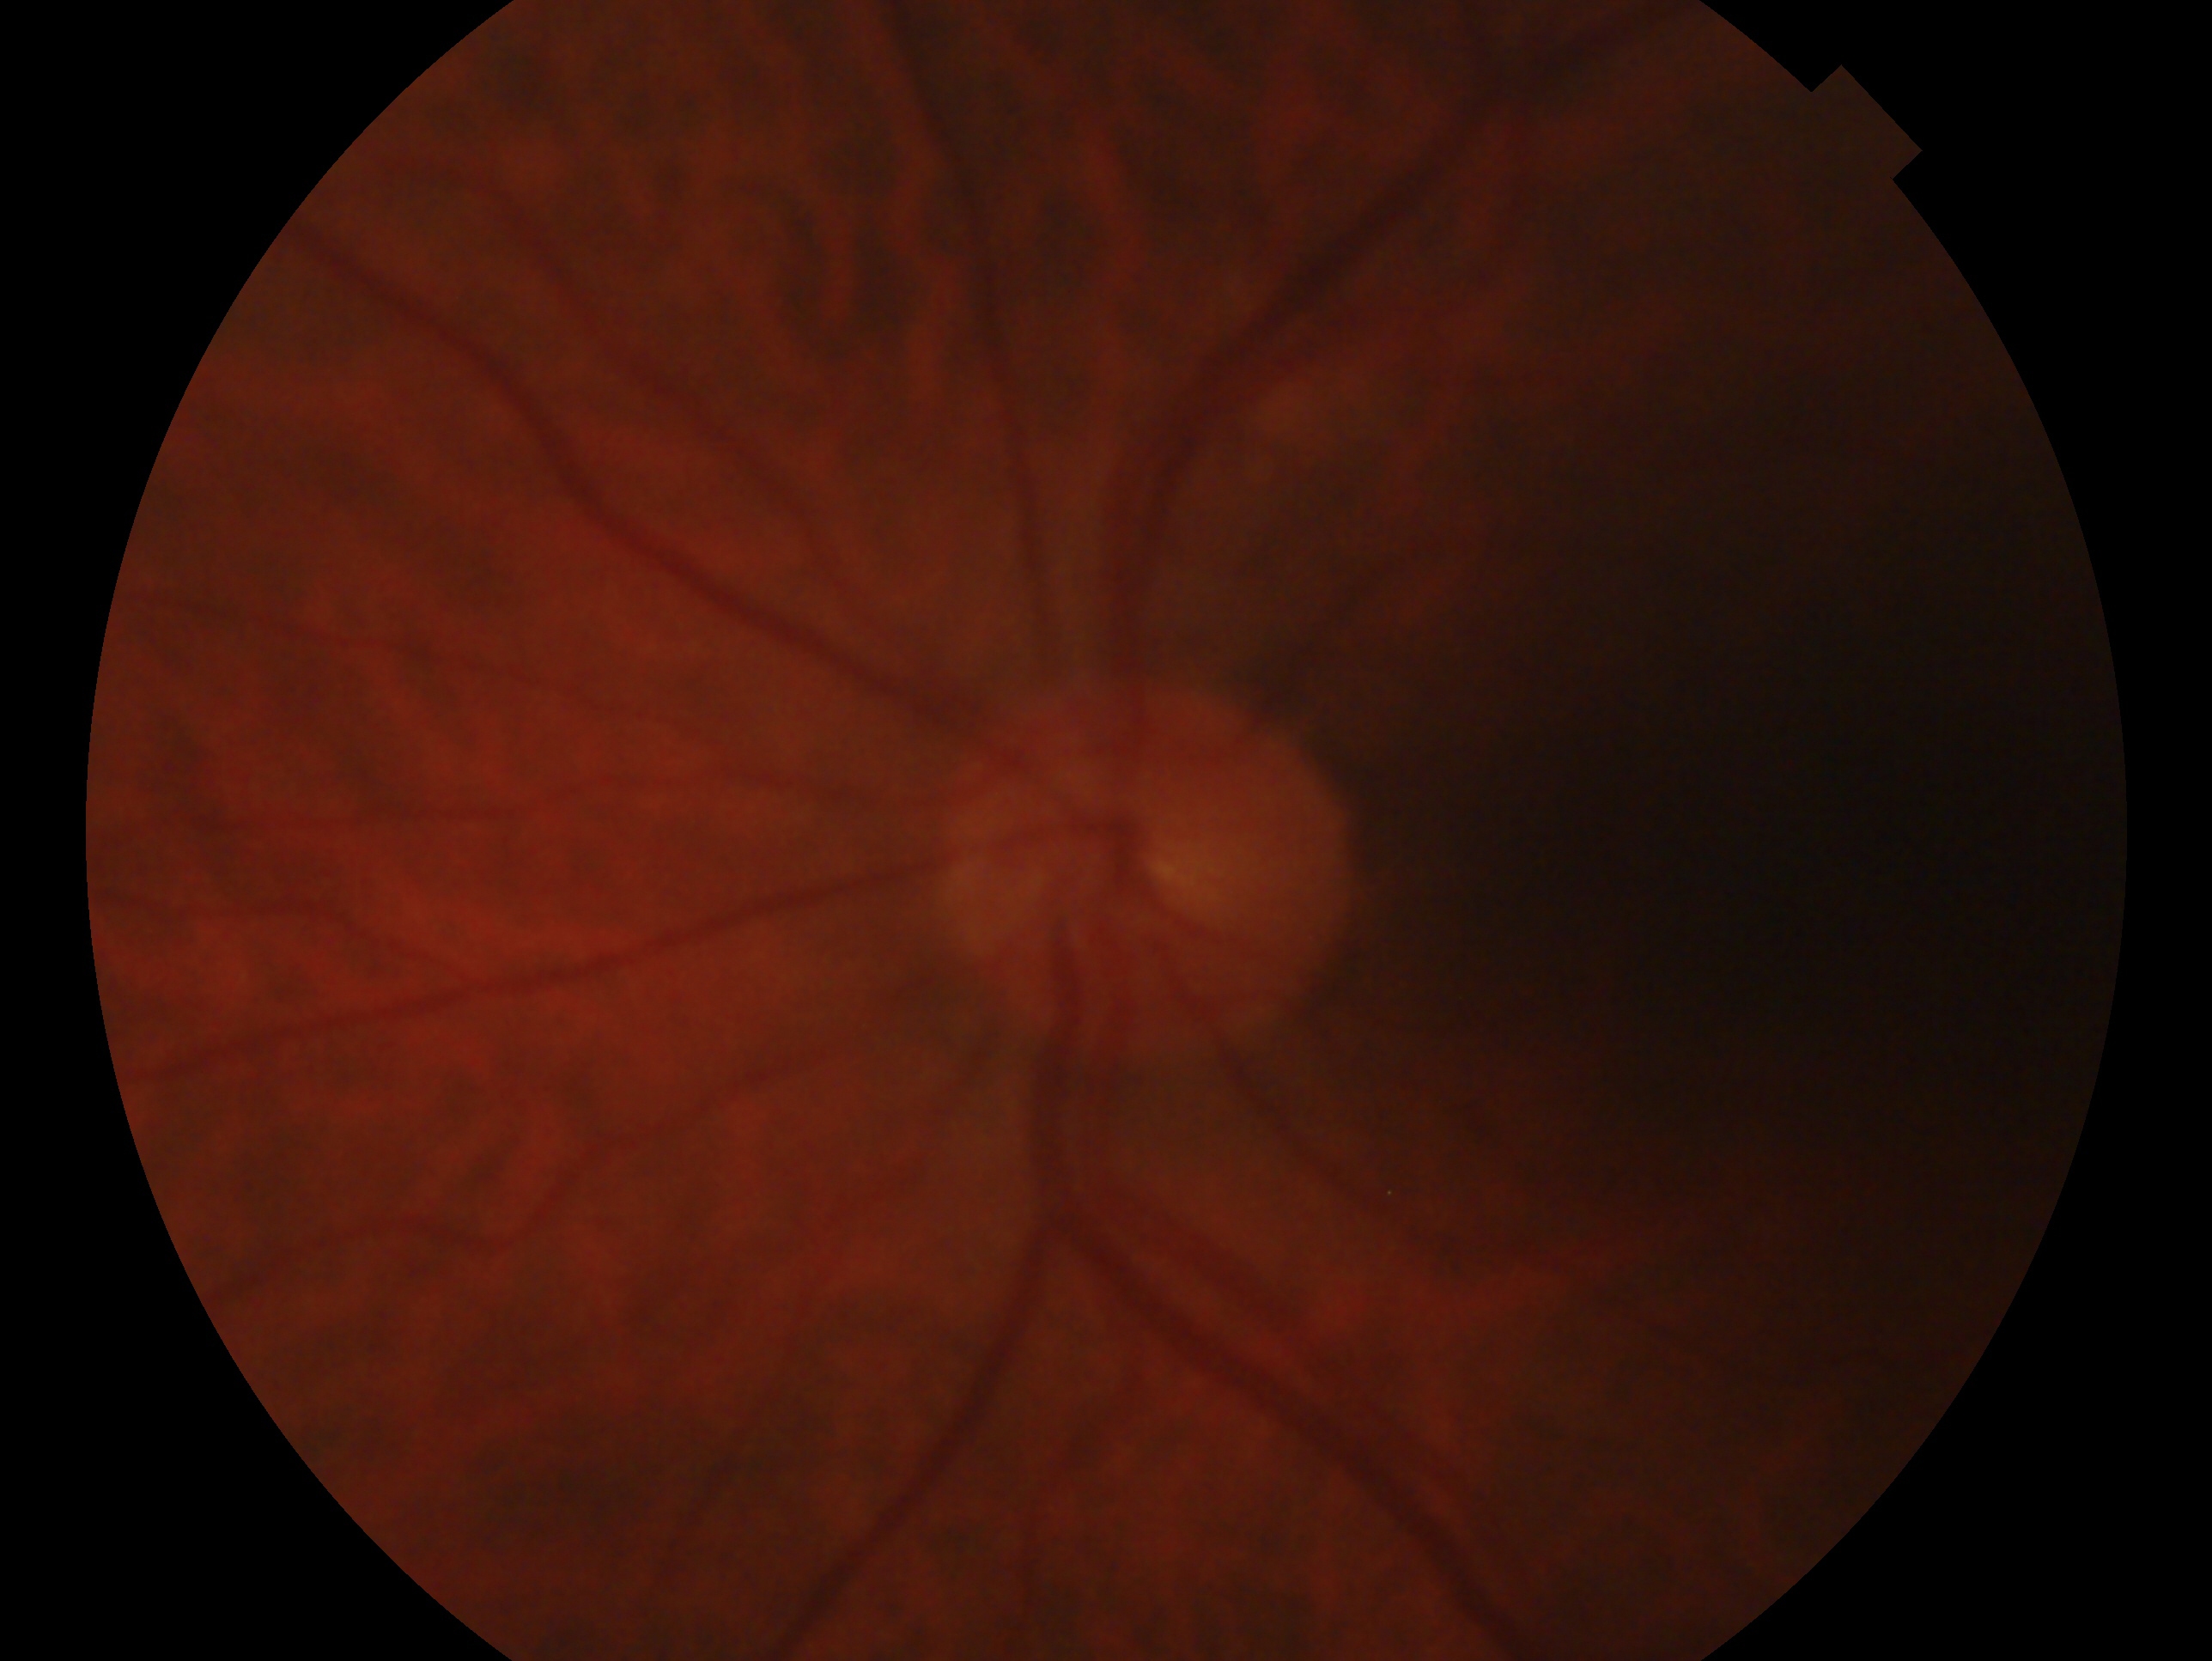 This is the OS. Clinical classification — no signs of glaucoma.